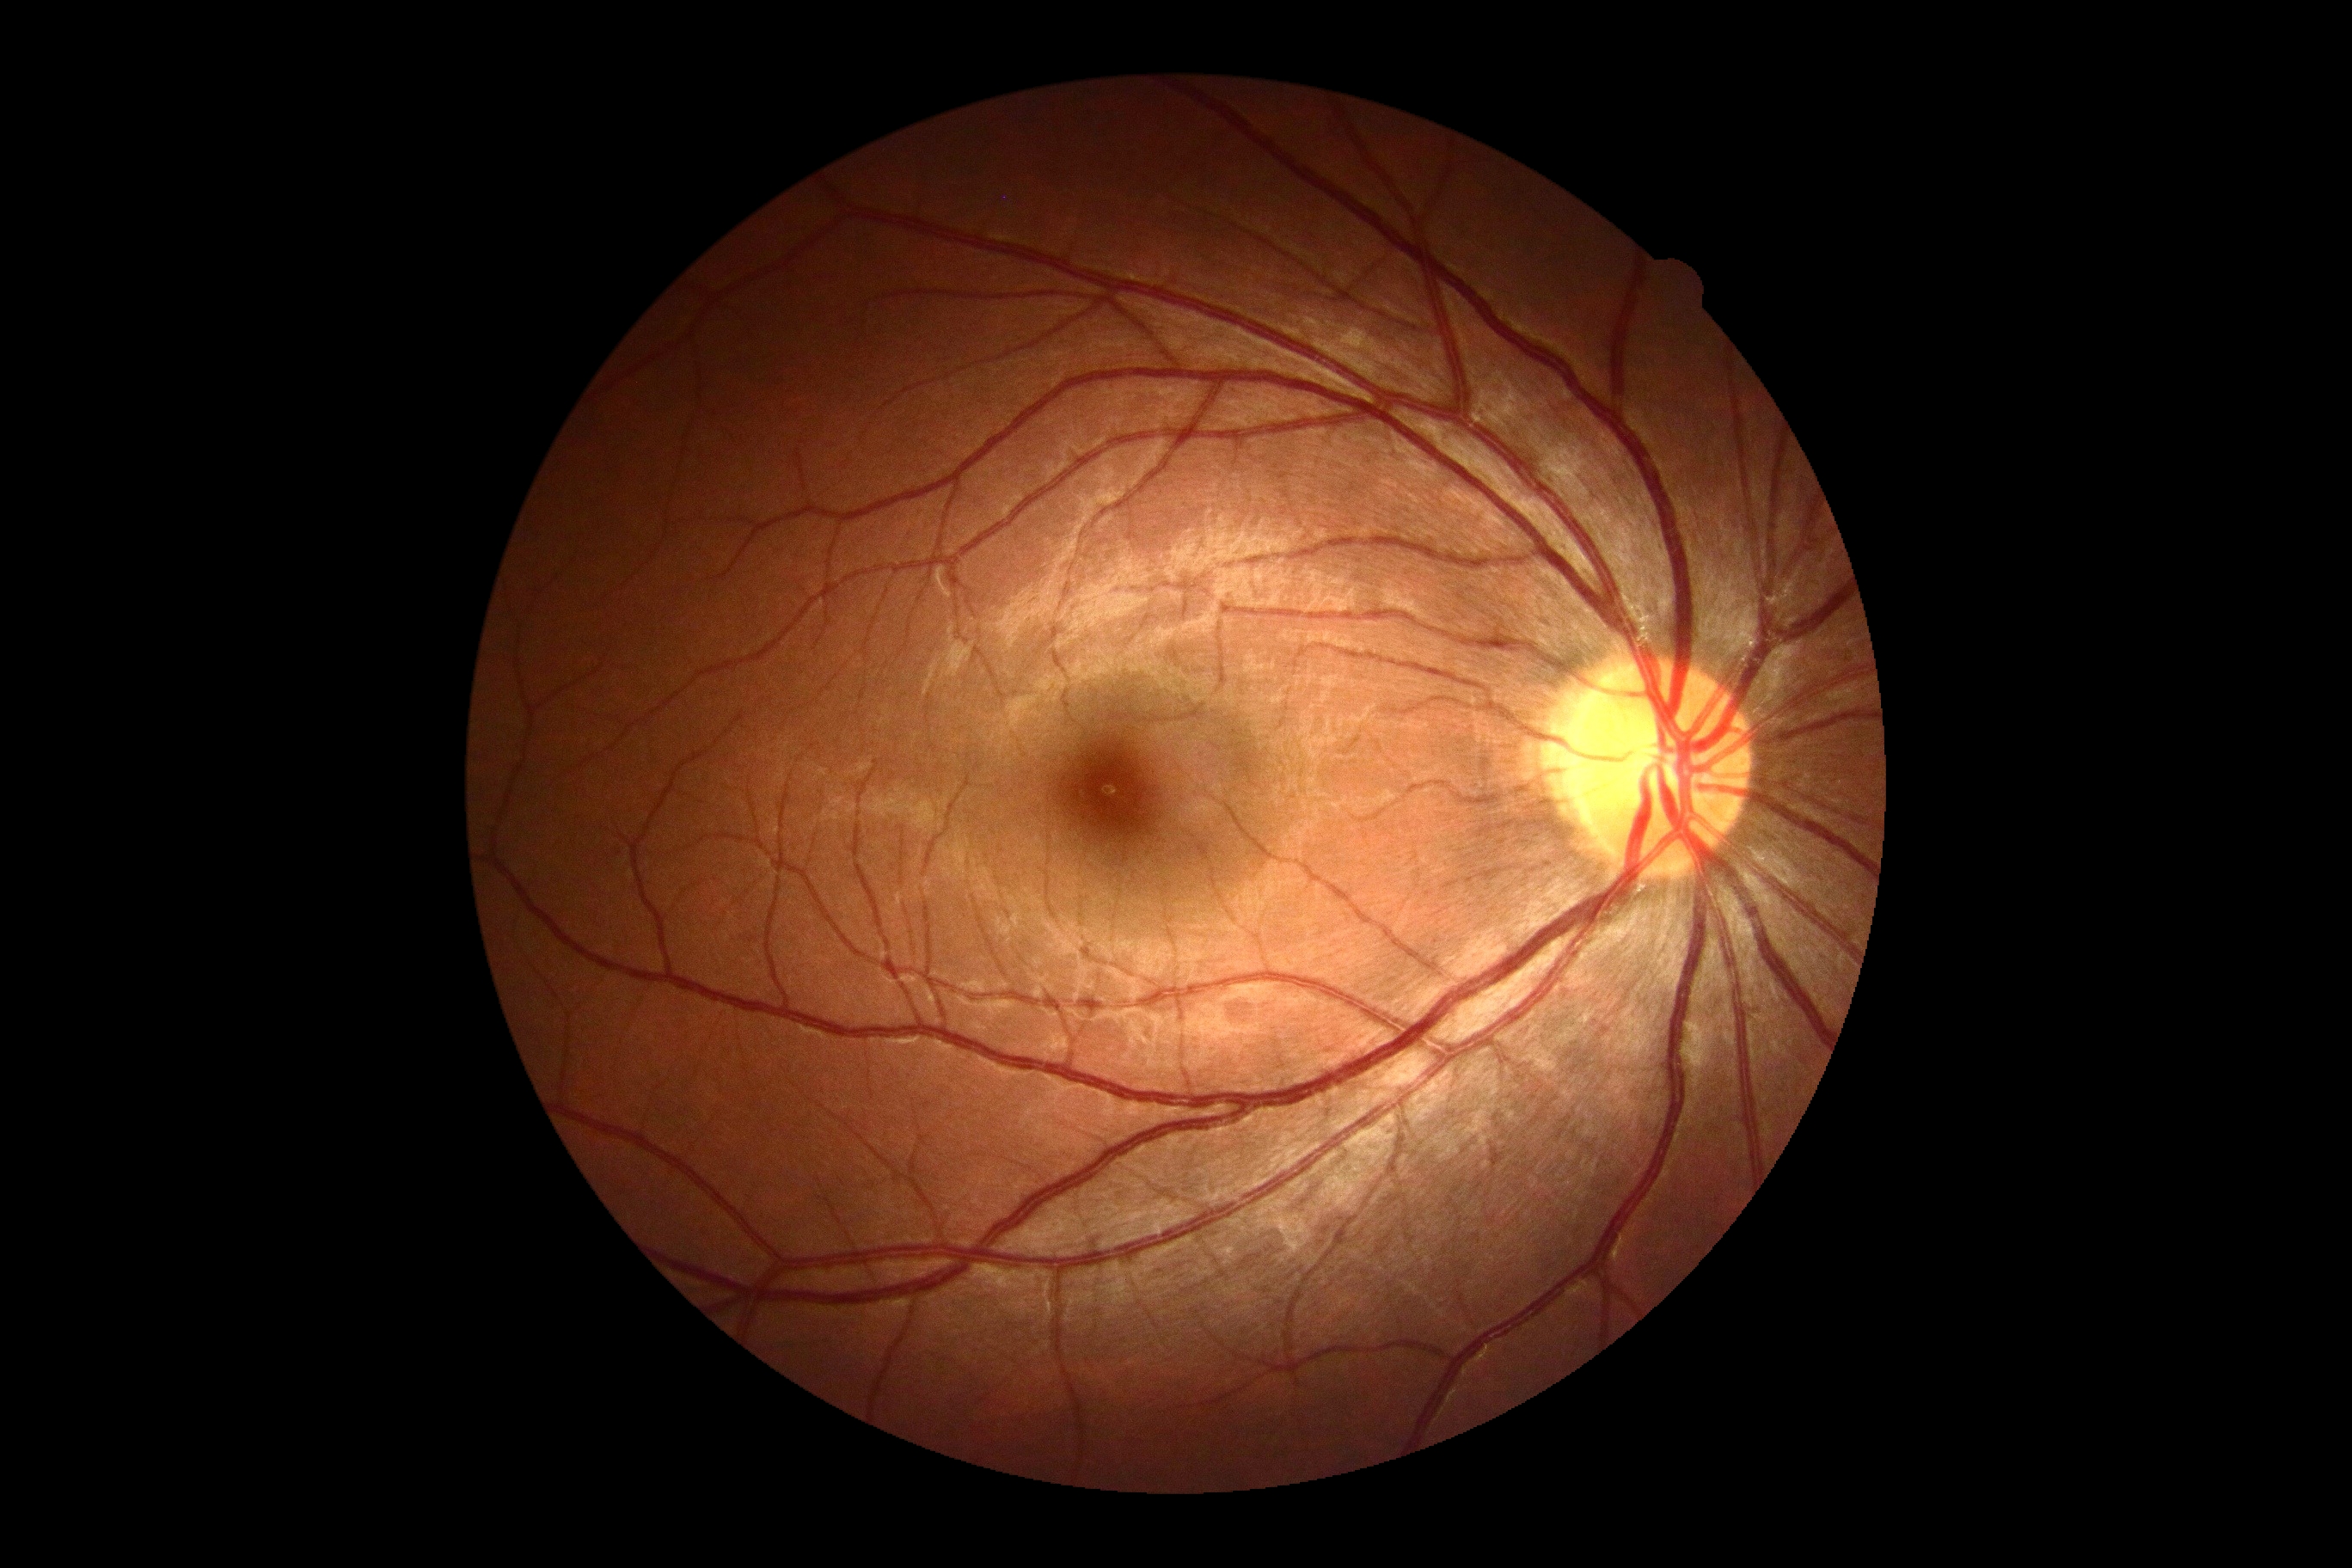
DR grade is 0/4.